Image size 640x480 · wide-field fundus image from infant ROP screening: 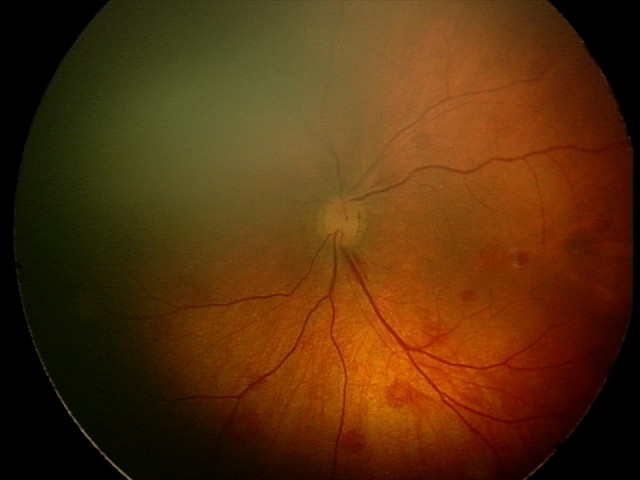

Screening diagnosis: retinal hemorrhages.